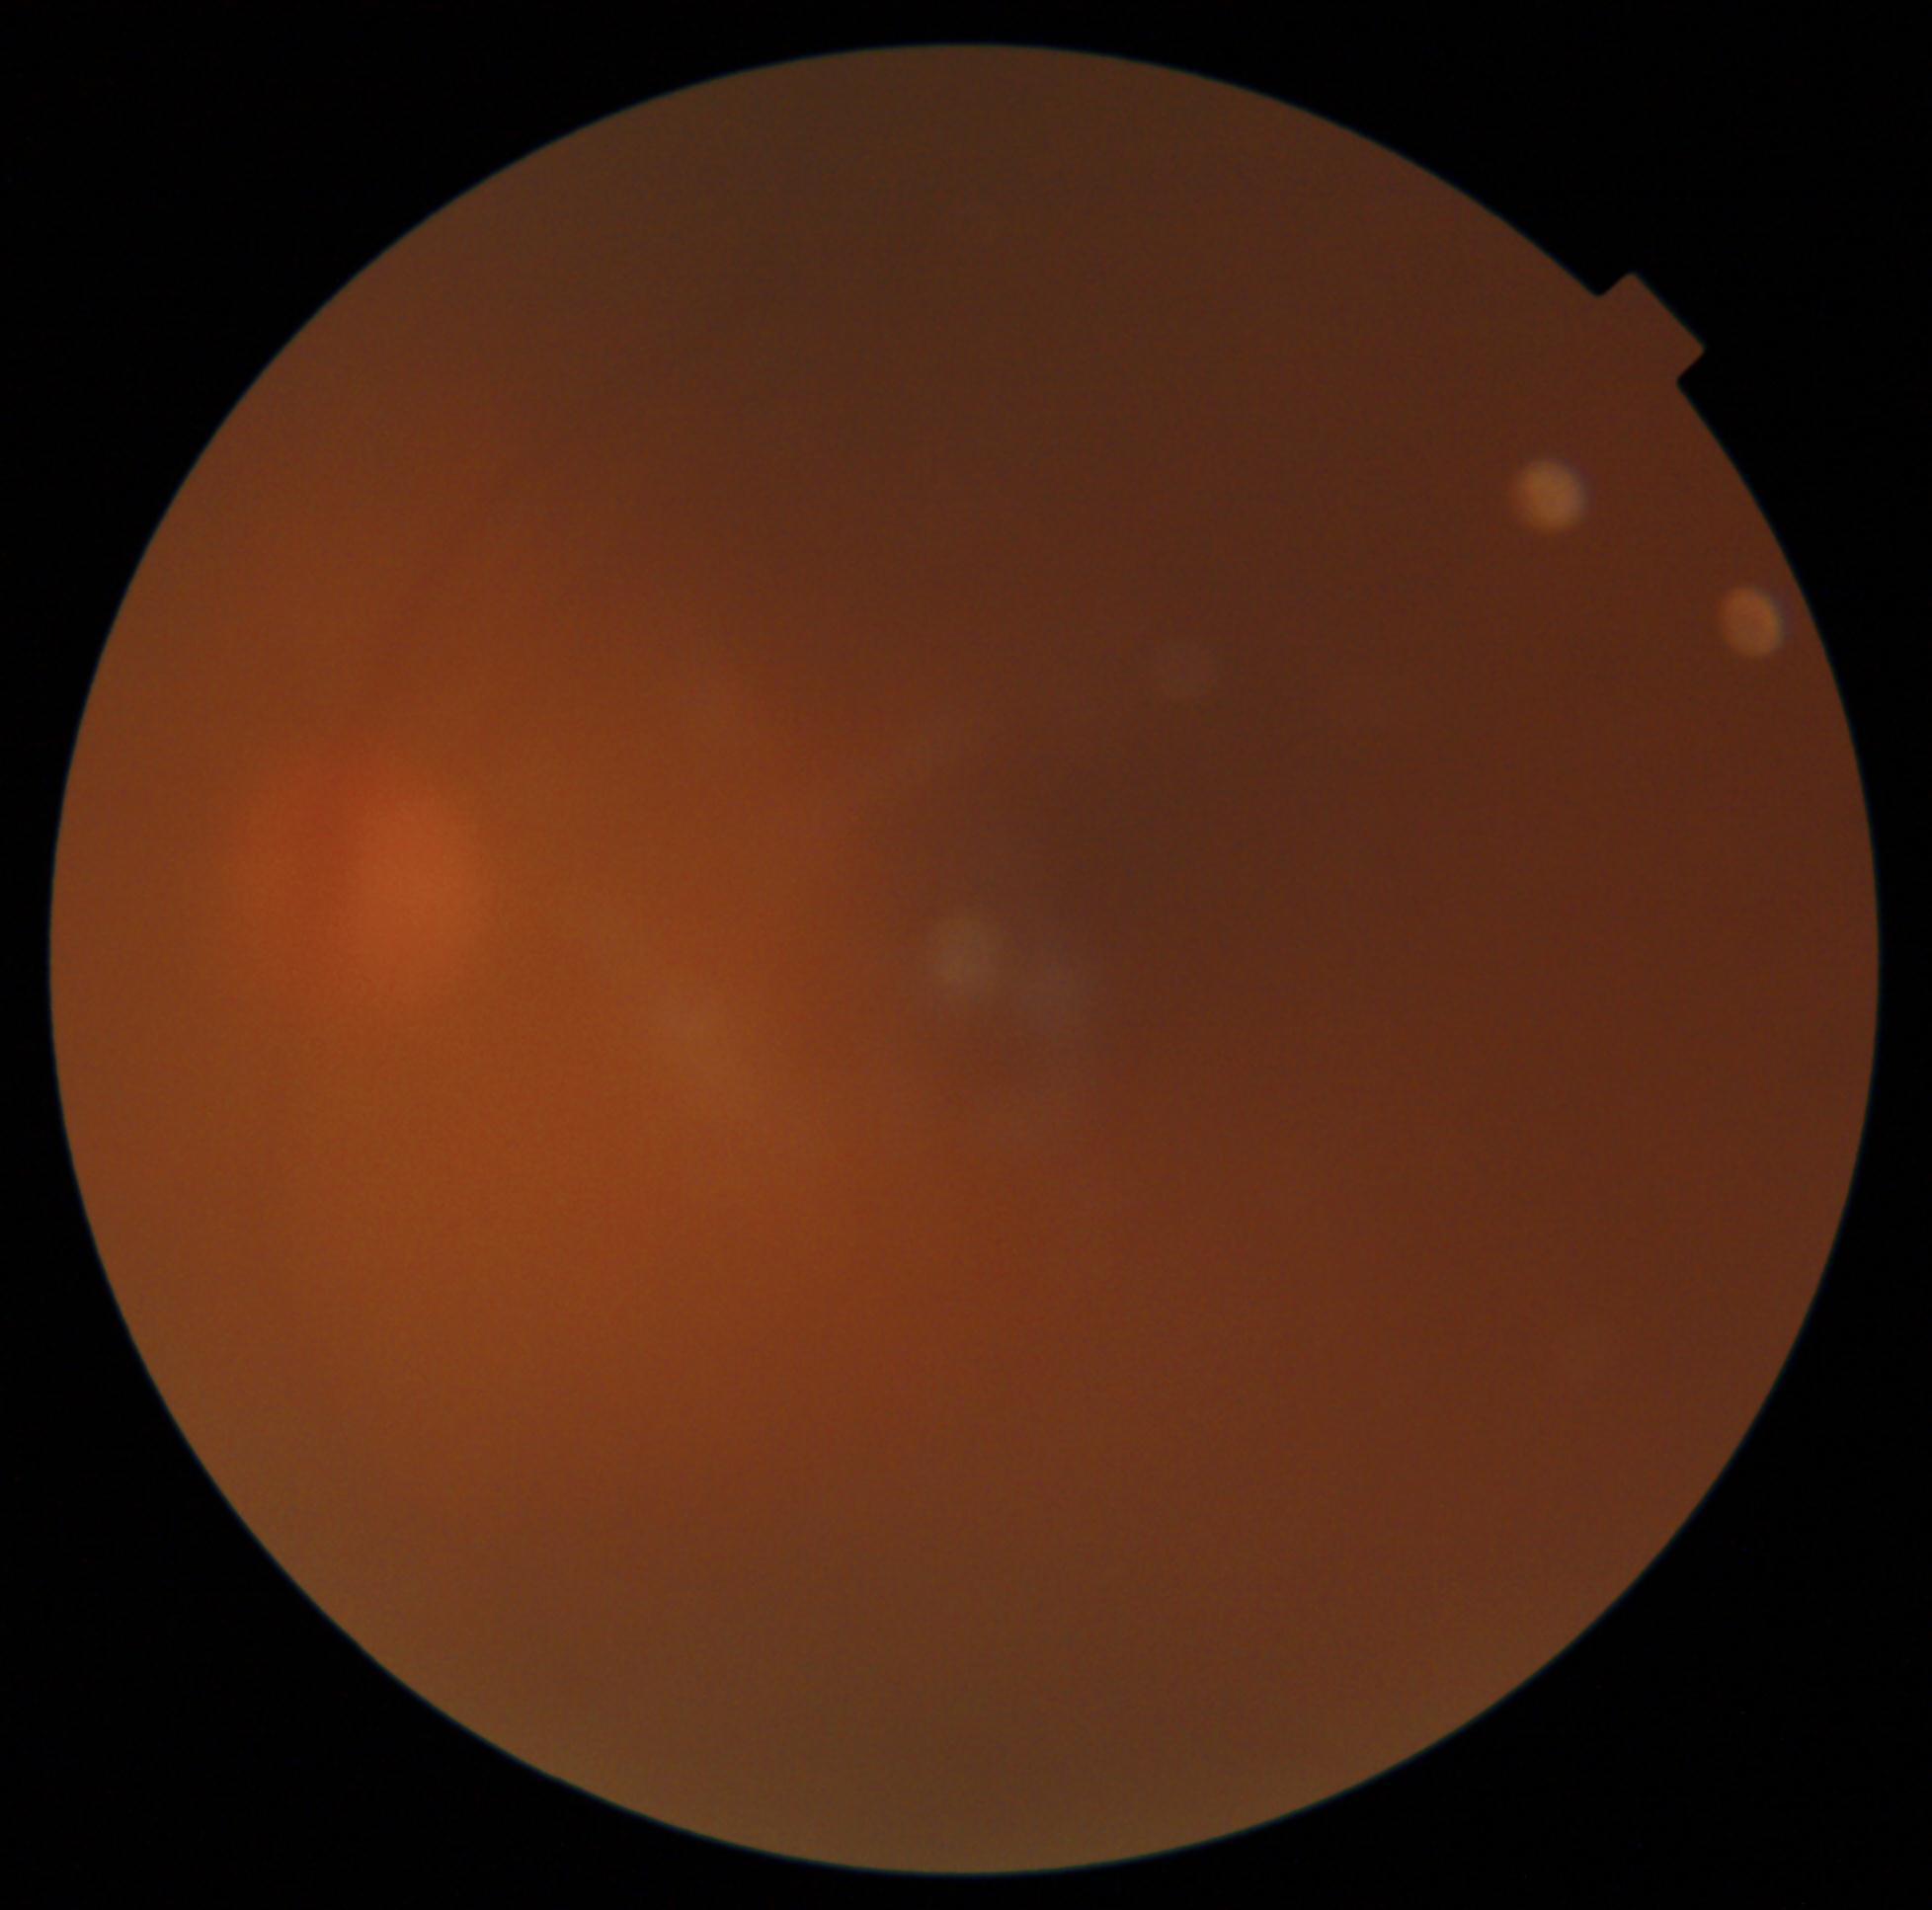
The image cannot be graded for diabetic retinopathy.
DR: ungradable.